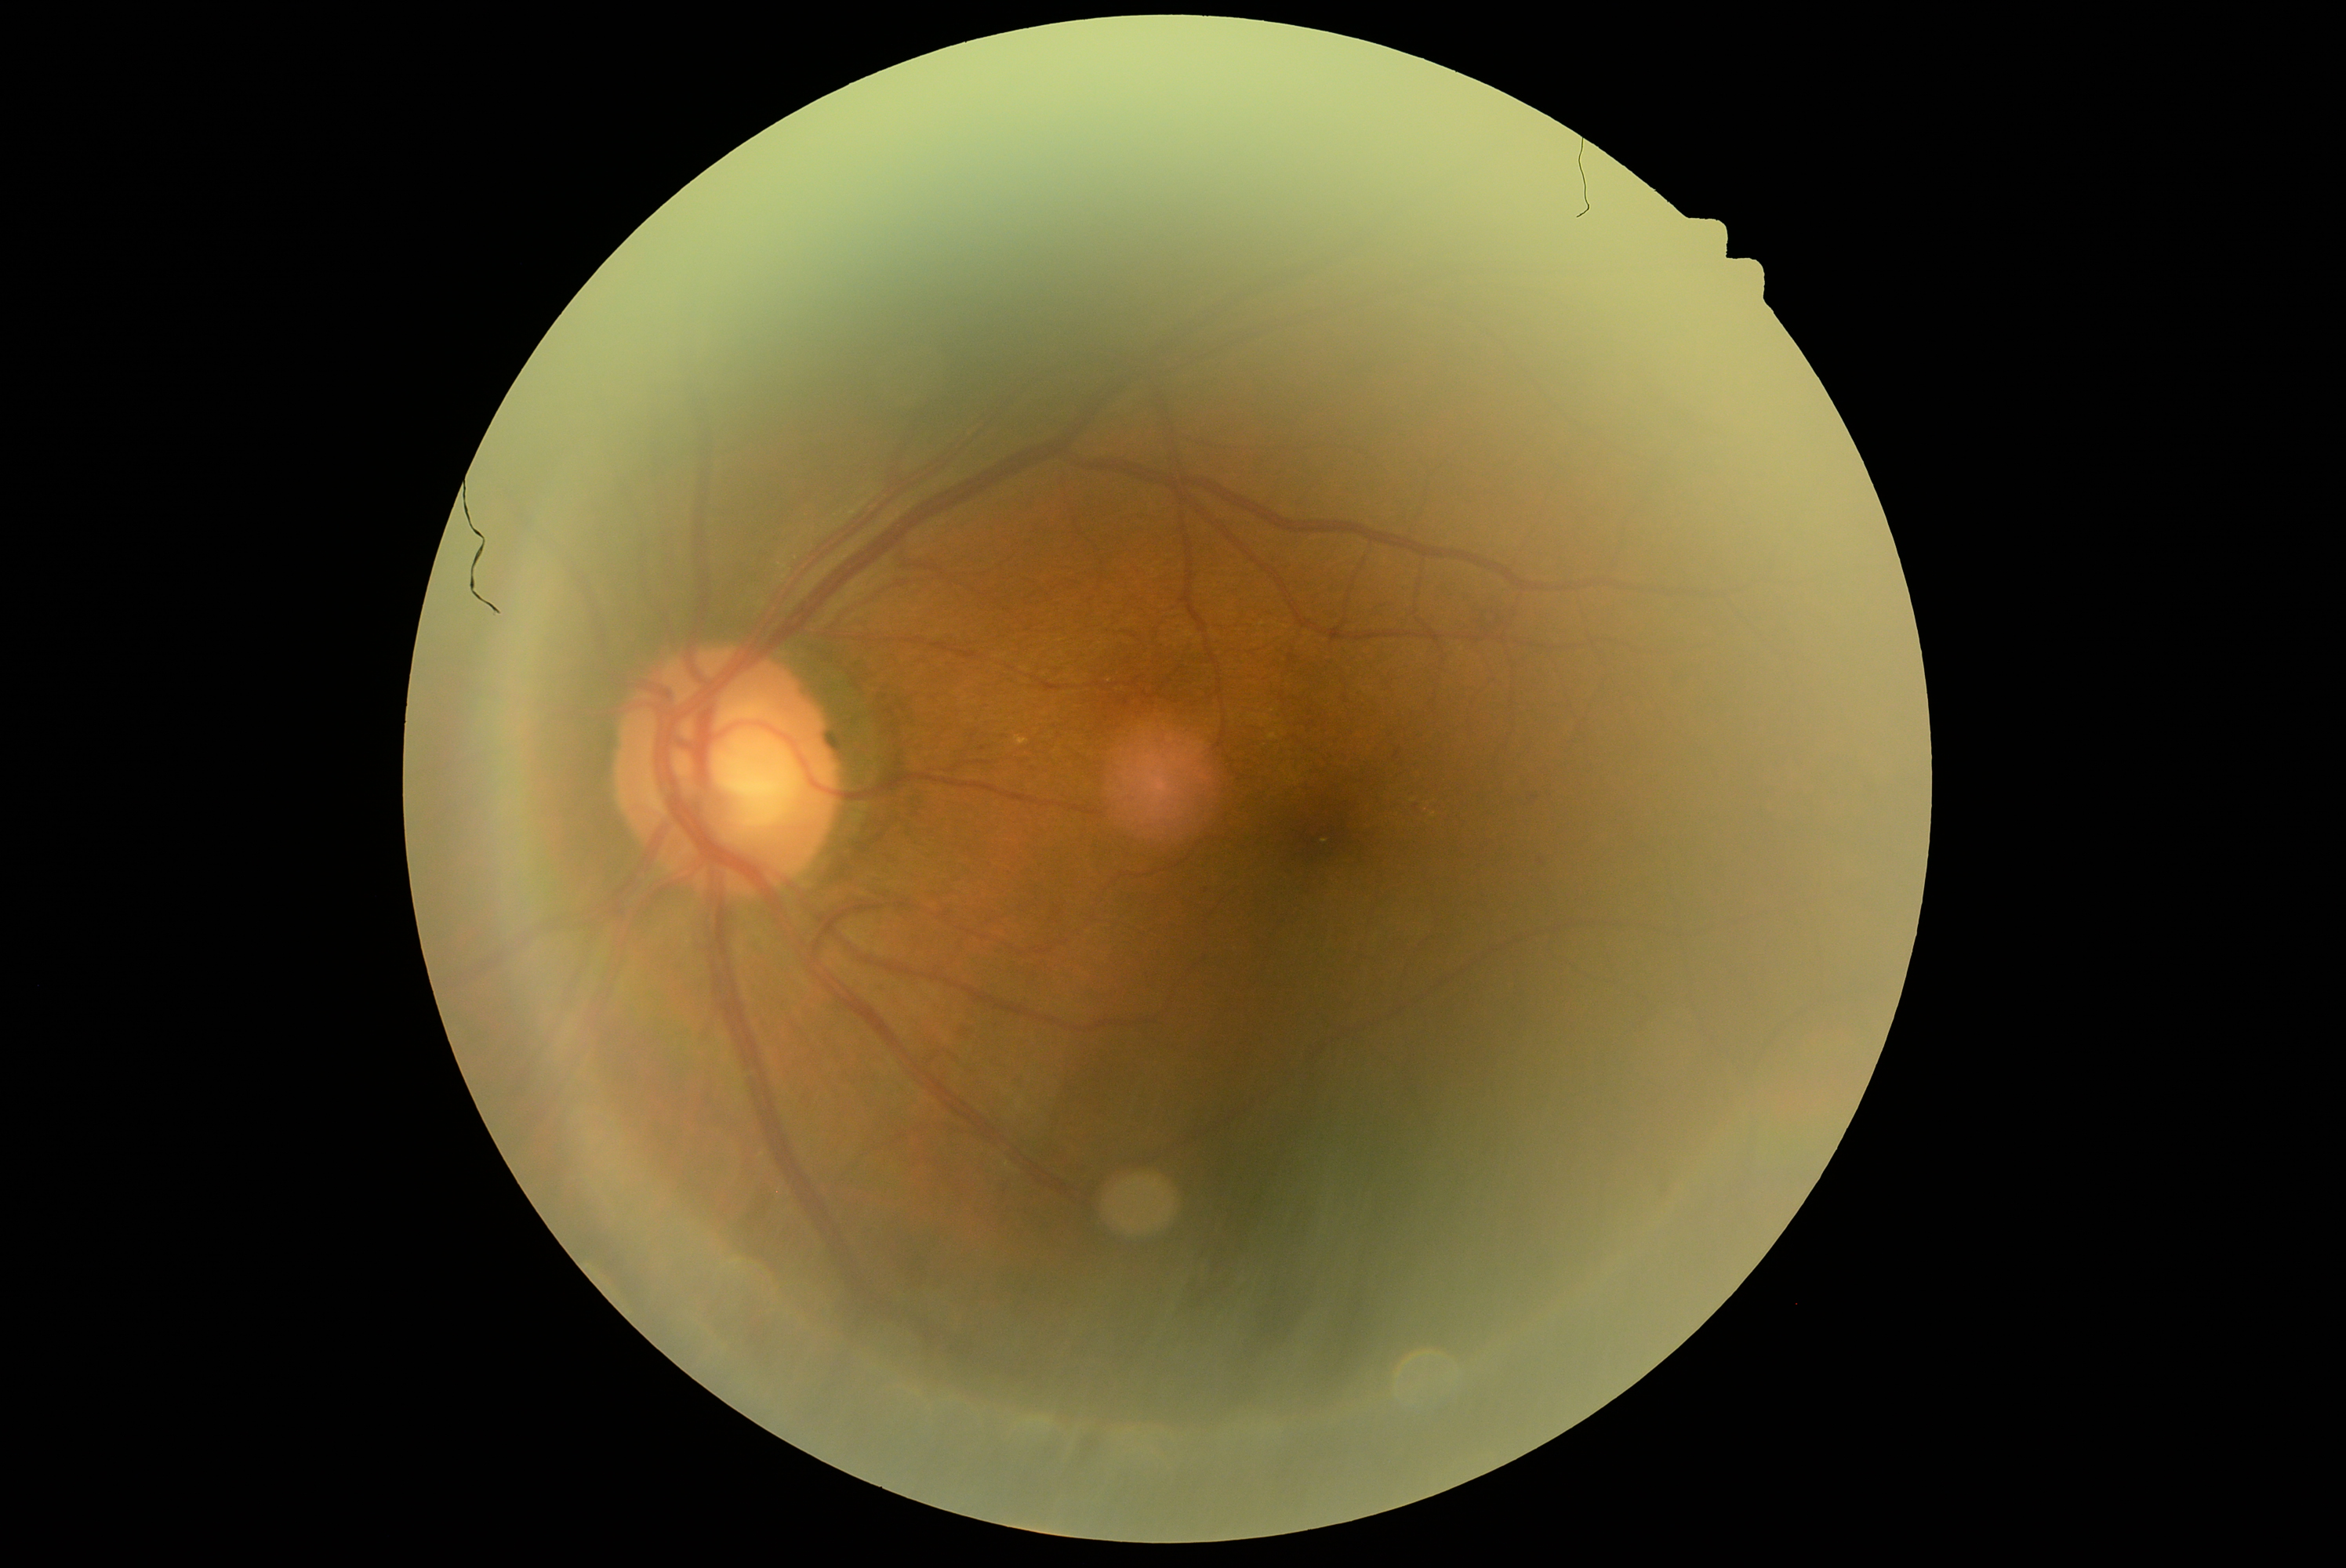
Disease class: non-proliferative diabetic retinopathy.
DR: moderate non-proliferative diabetic retinopathy (grade 2) — more than just microaneurysms but less than severe NPDR.